Diabetic retinopathy graded by the modified Davis classification
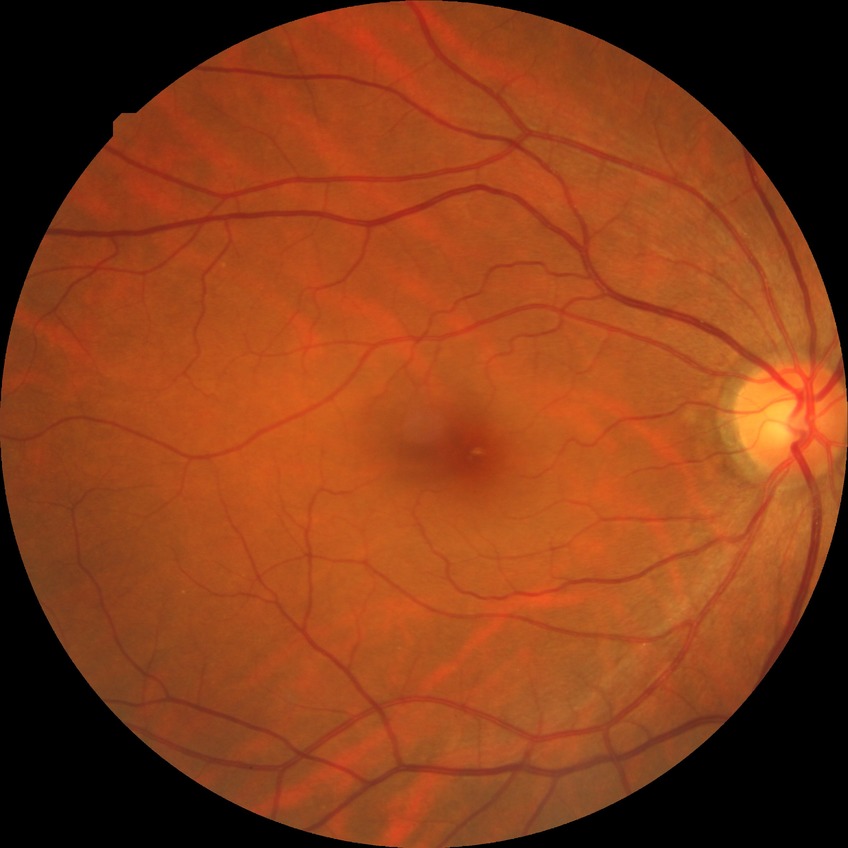 Diabetic retinopathy (DR): no diabetic retinopathy (NDR).